848 x 848 pixels: 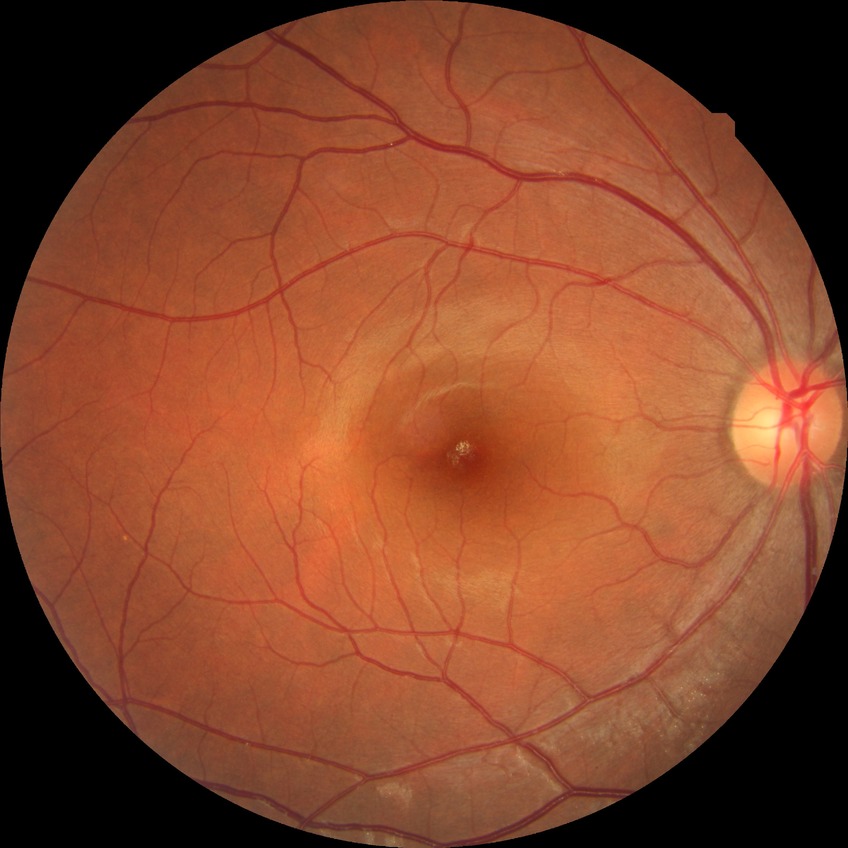 diabetic retinopathy (DR): NDR (no diabetic retinopathy).